45-degree field of view — 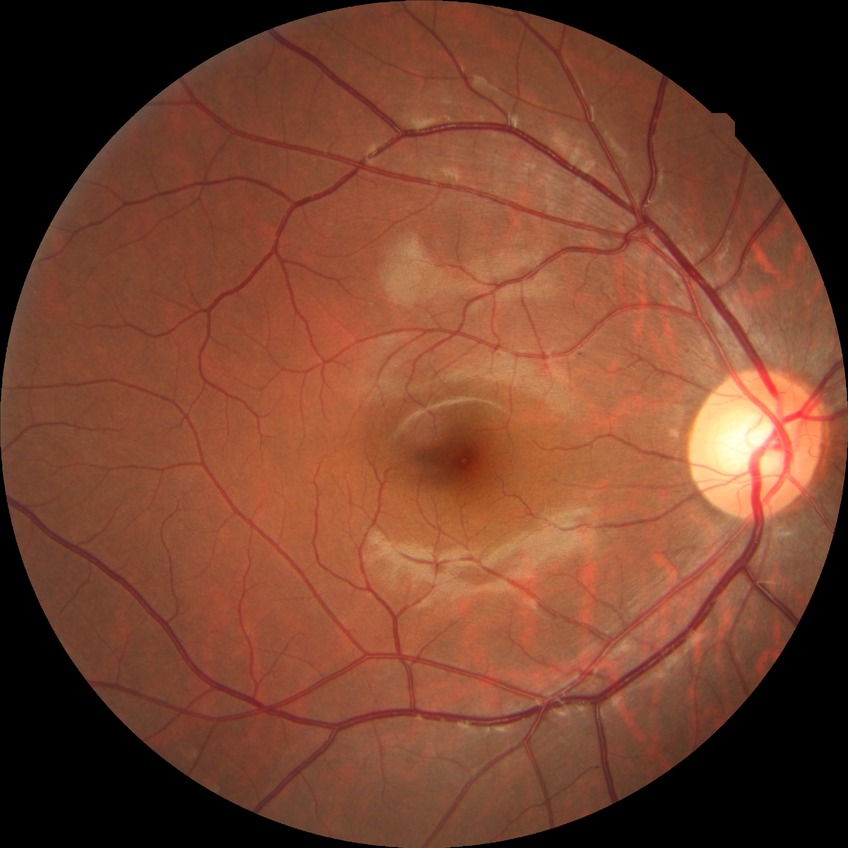

Diabetic retinopathy (DR) is NDR (no diabetic retinopathy).